2102 x 1736 pixels:
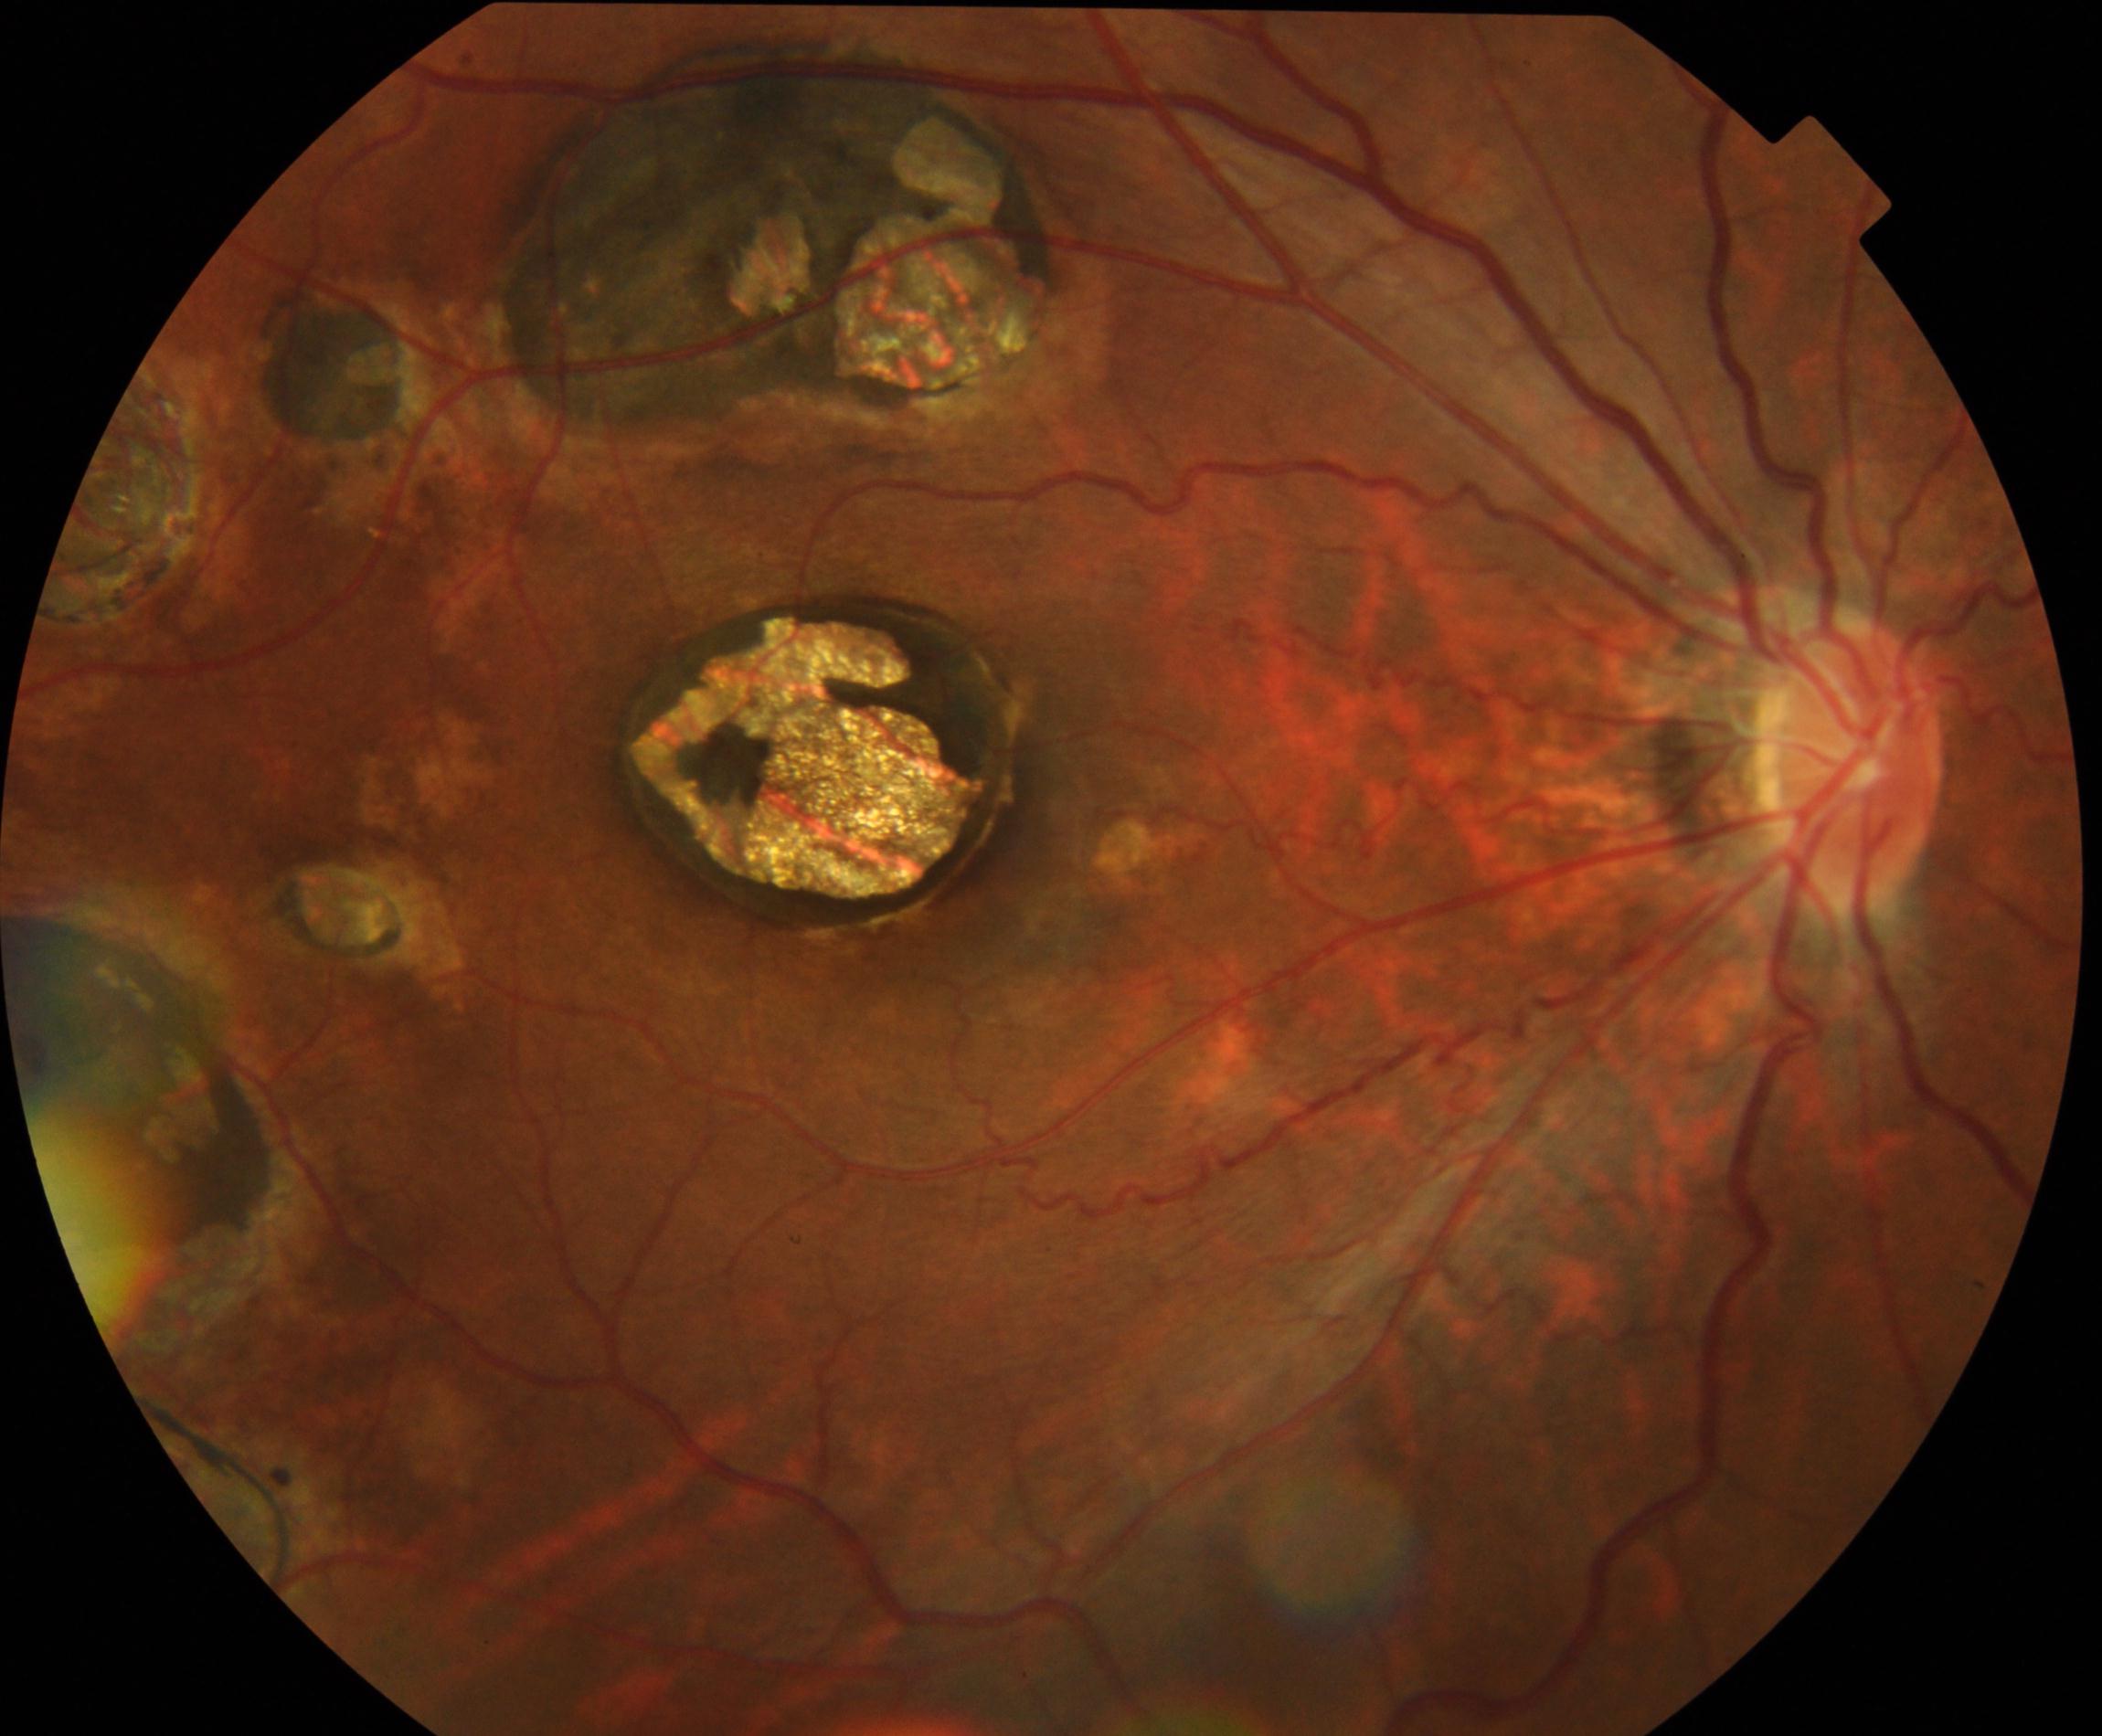 Classification: chorioretinal atrophy or coloboma.